Color fundus image, image size 1624x1232, 45° FOV.
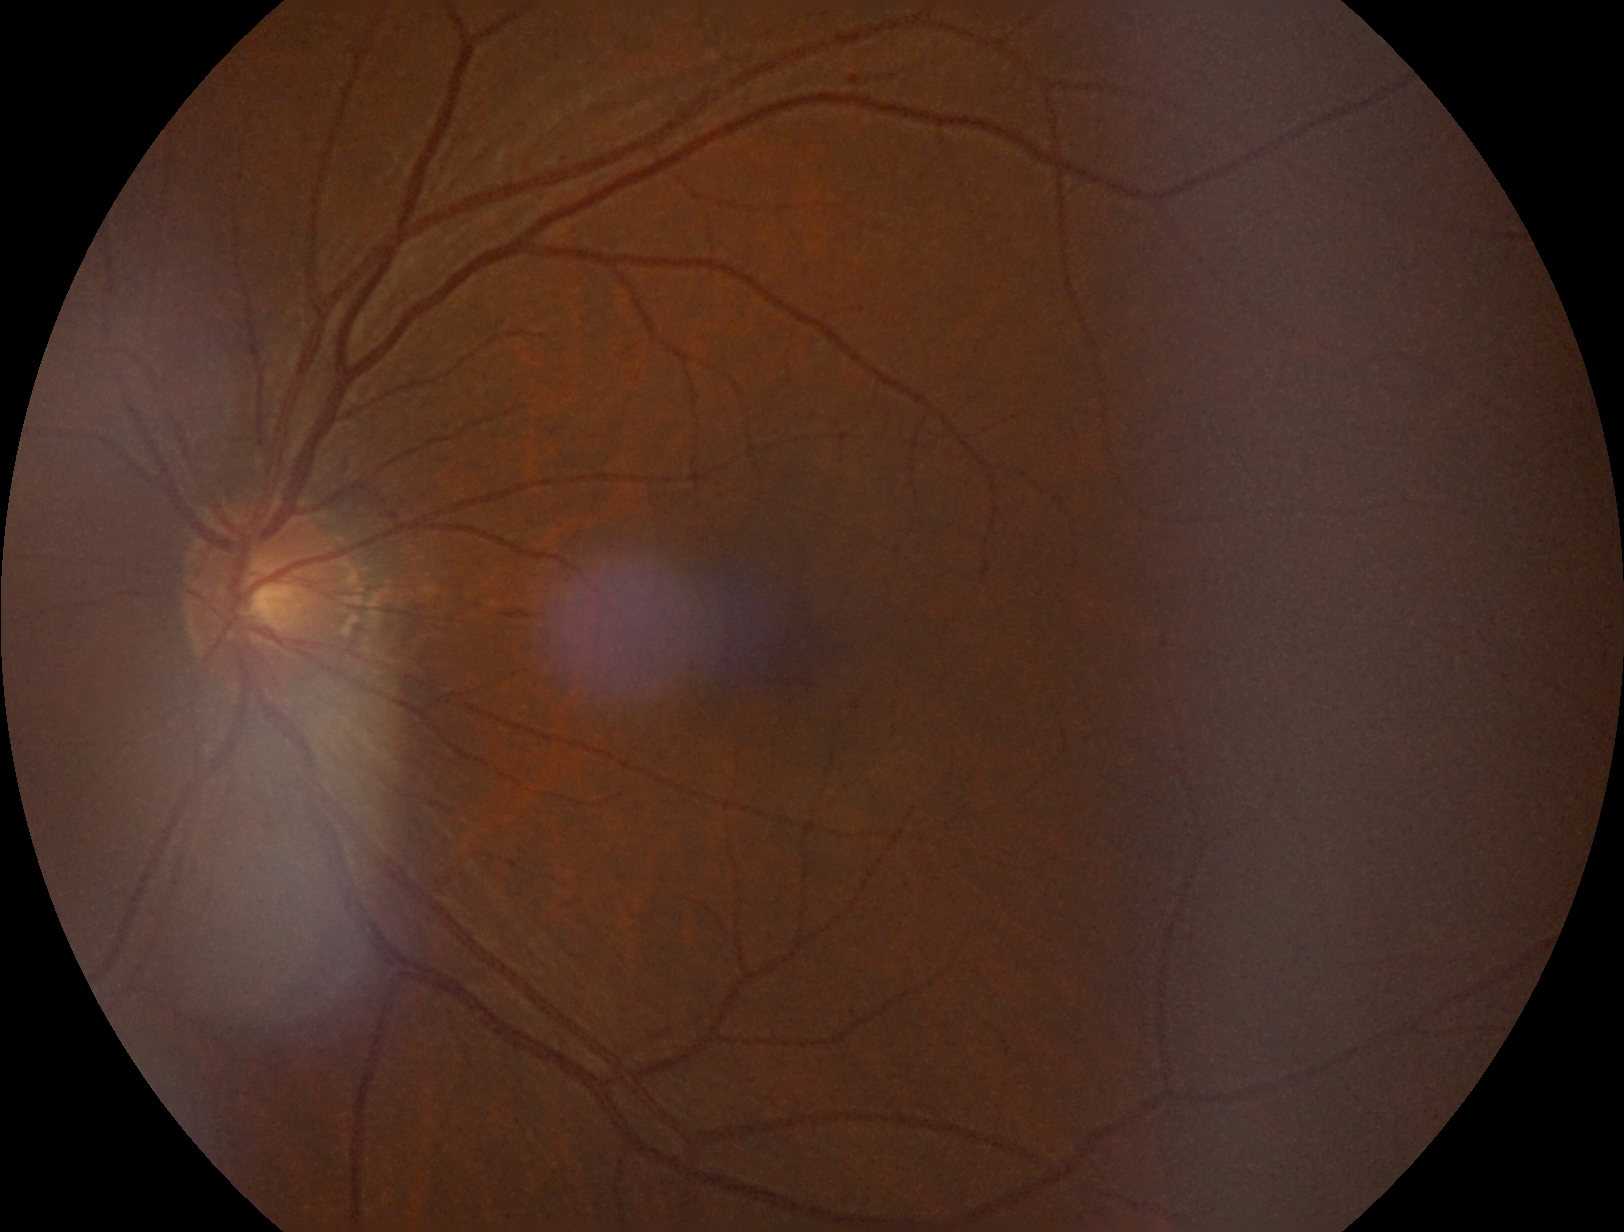 diabetic retinopathy (DR) = grade 2 (moderate NPDR).